NIDEK AFC-230 fundus camera:
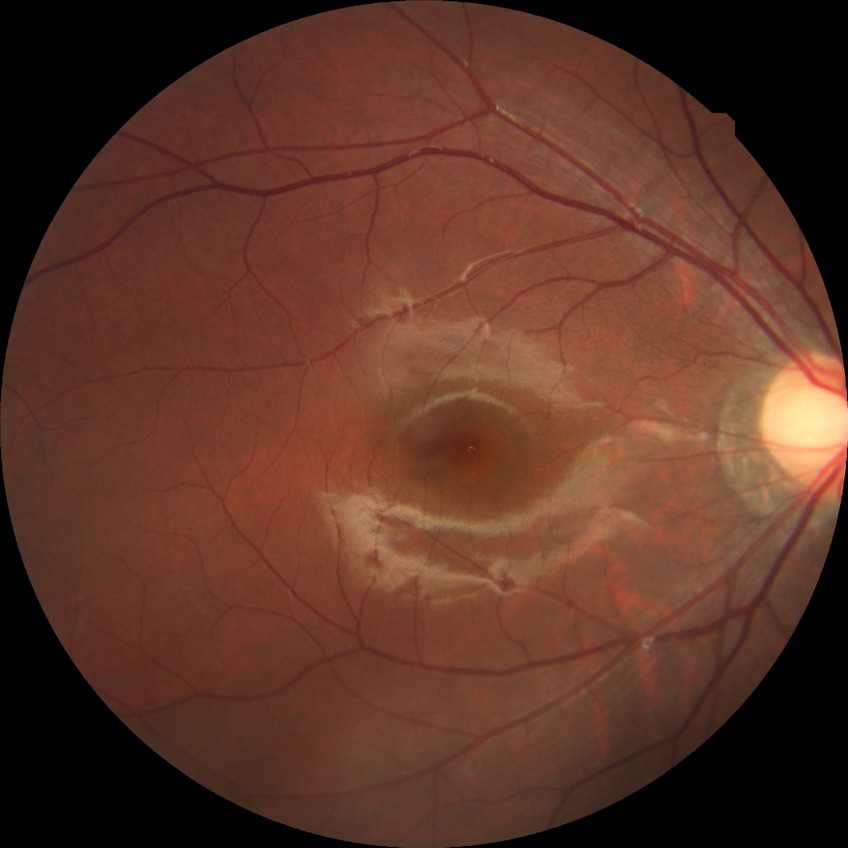 davis_grade: NDR
dr_impression: no signs of DR